Phoenix ICON wide-field infant fundus image — 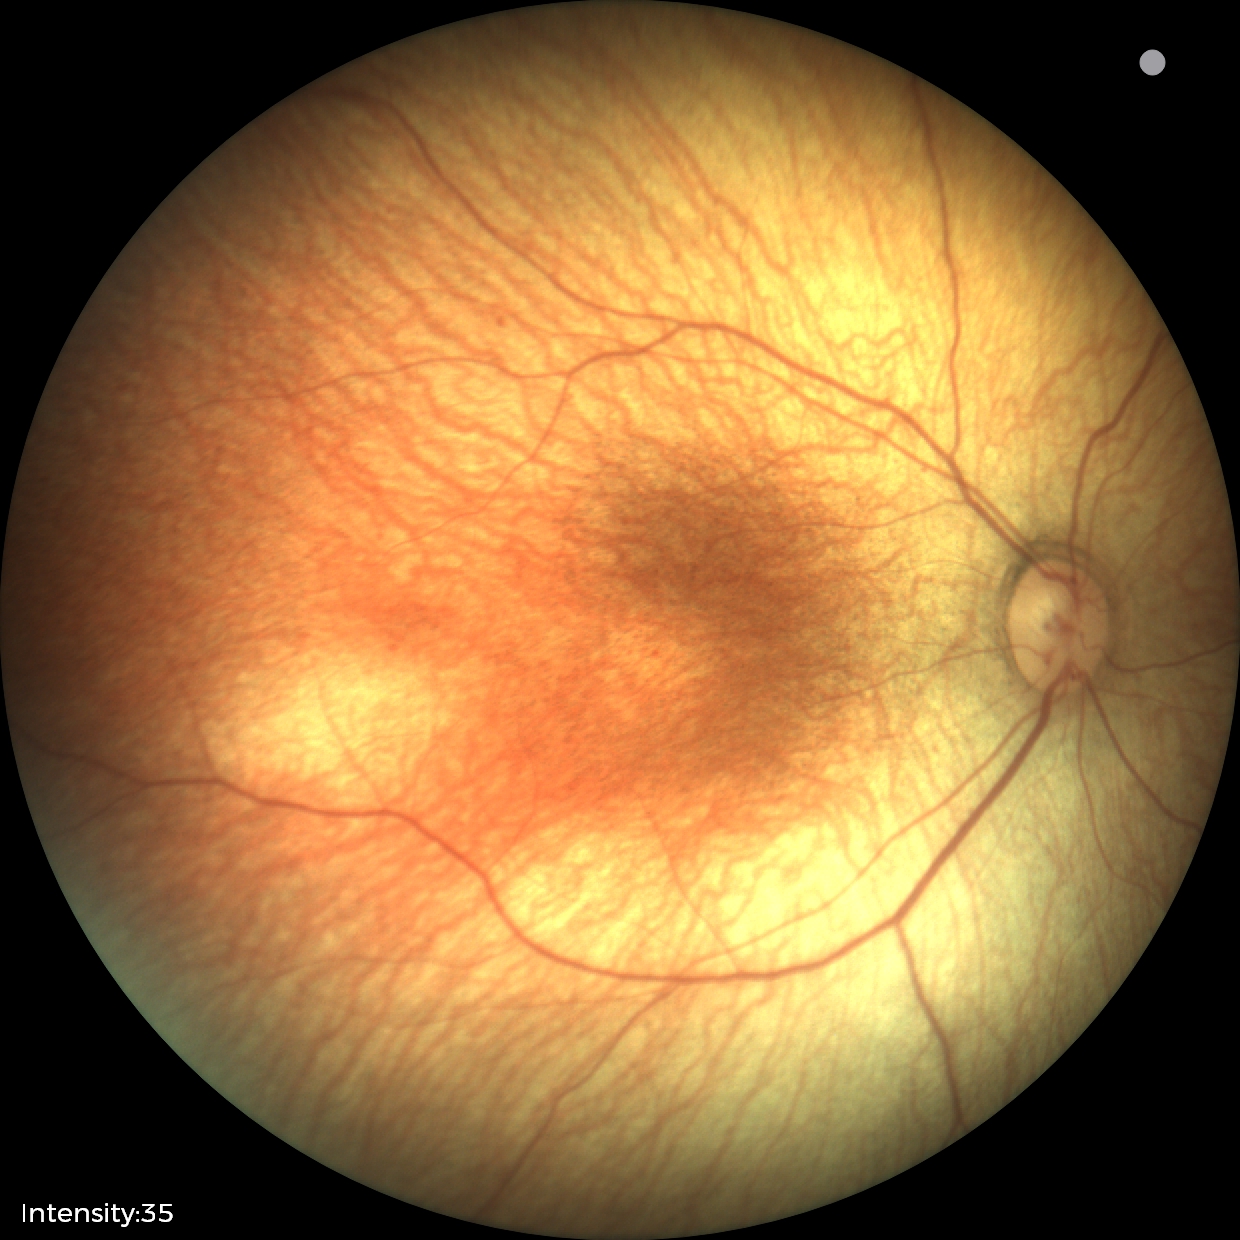
Assessment: physiological.